1240 by 1240 pixels. Camera: Phoenix ICON (100° FOV). Wide-field fundus photograph of an infant
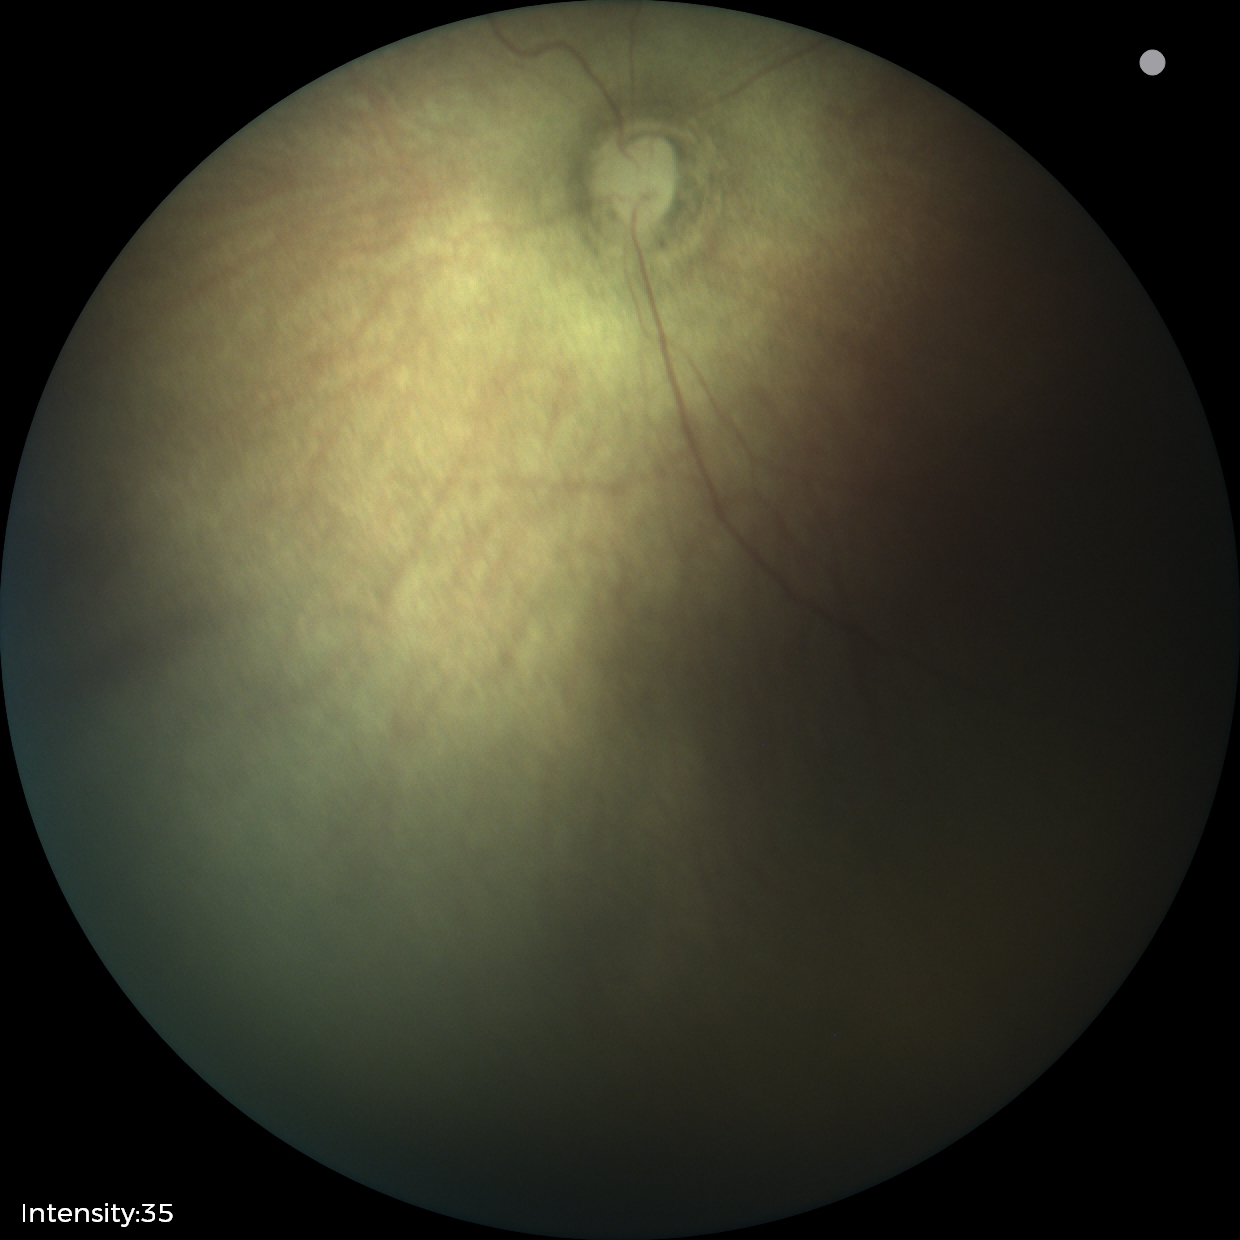 Plus form = absent, ROP diagnosis = stage 0.